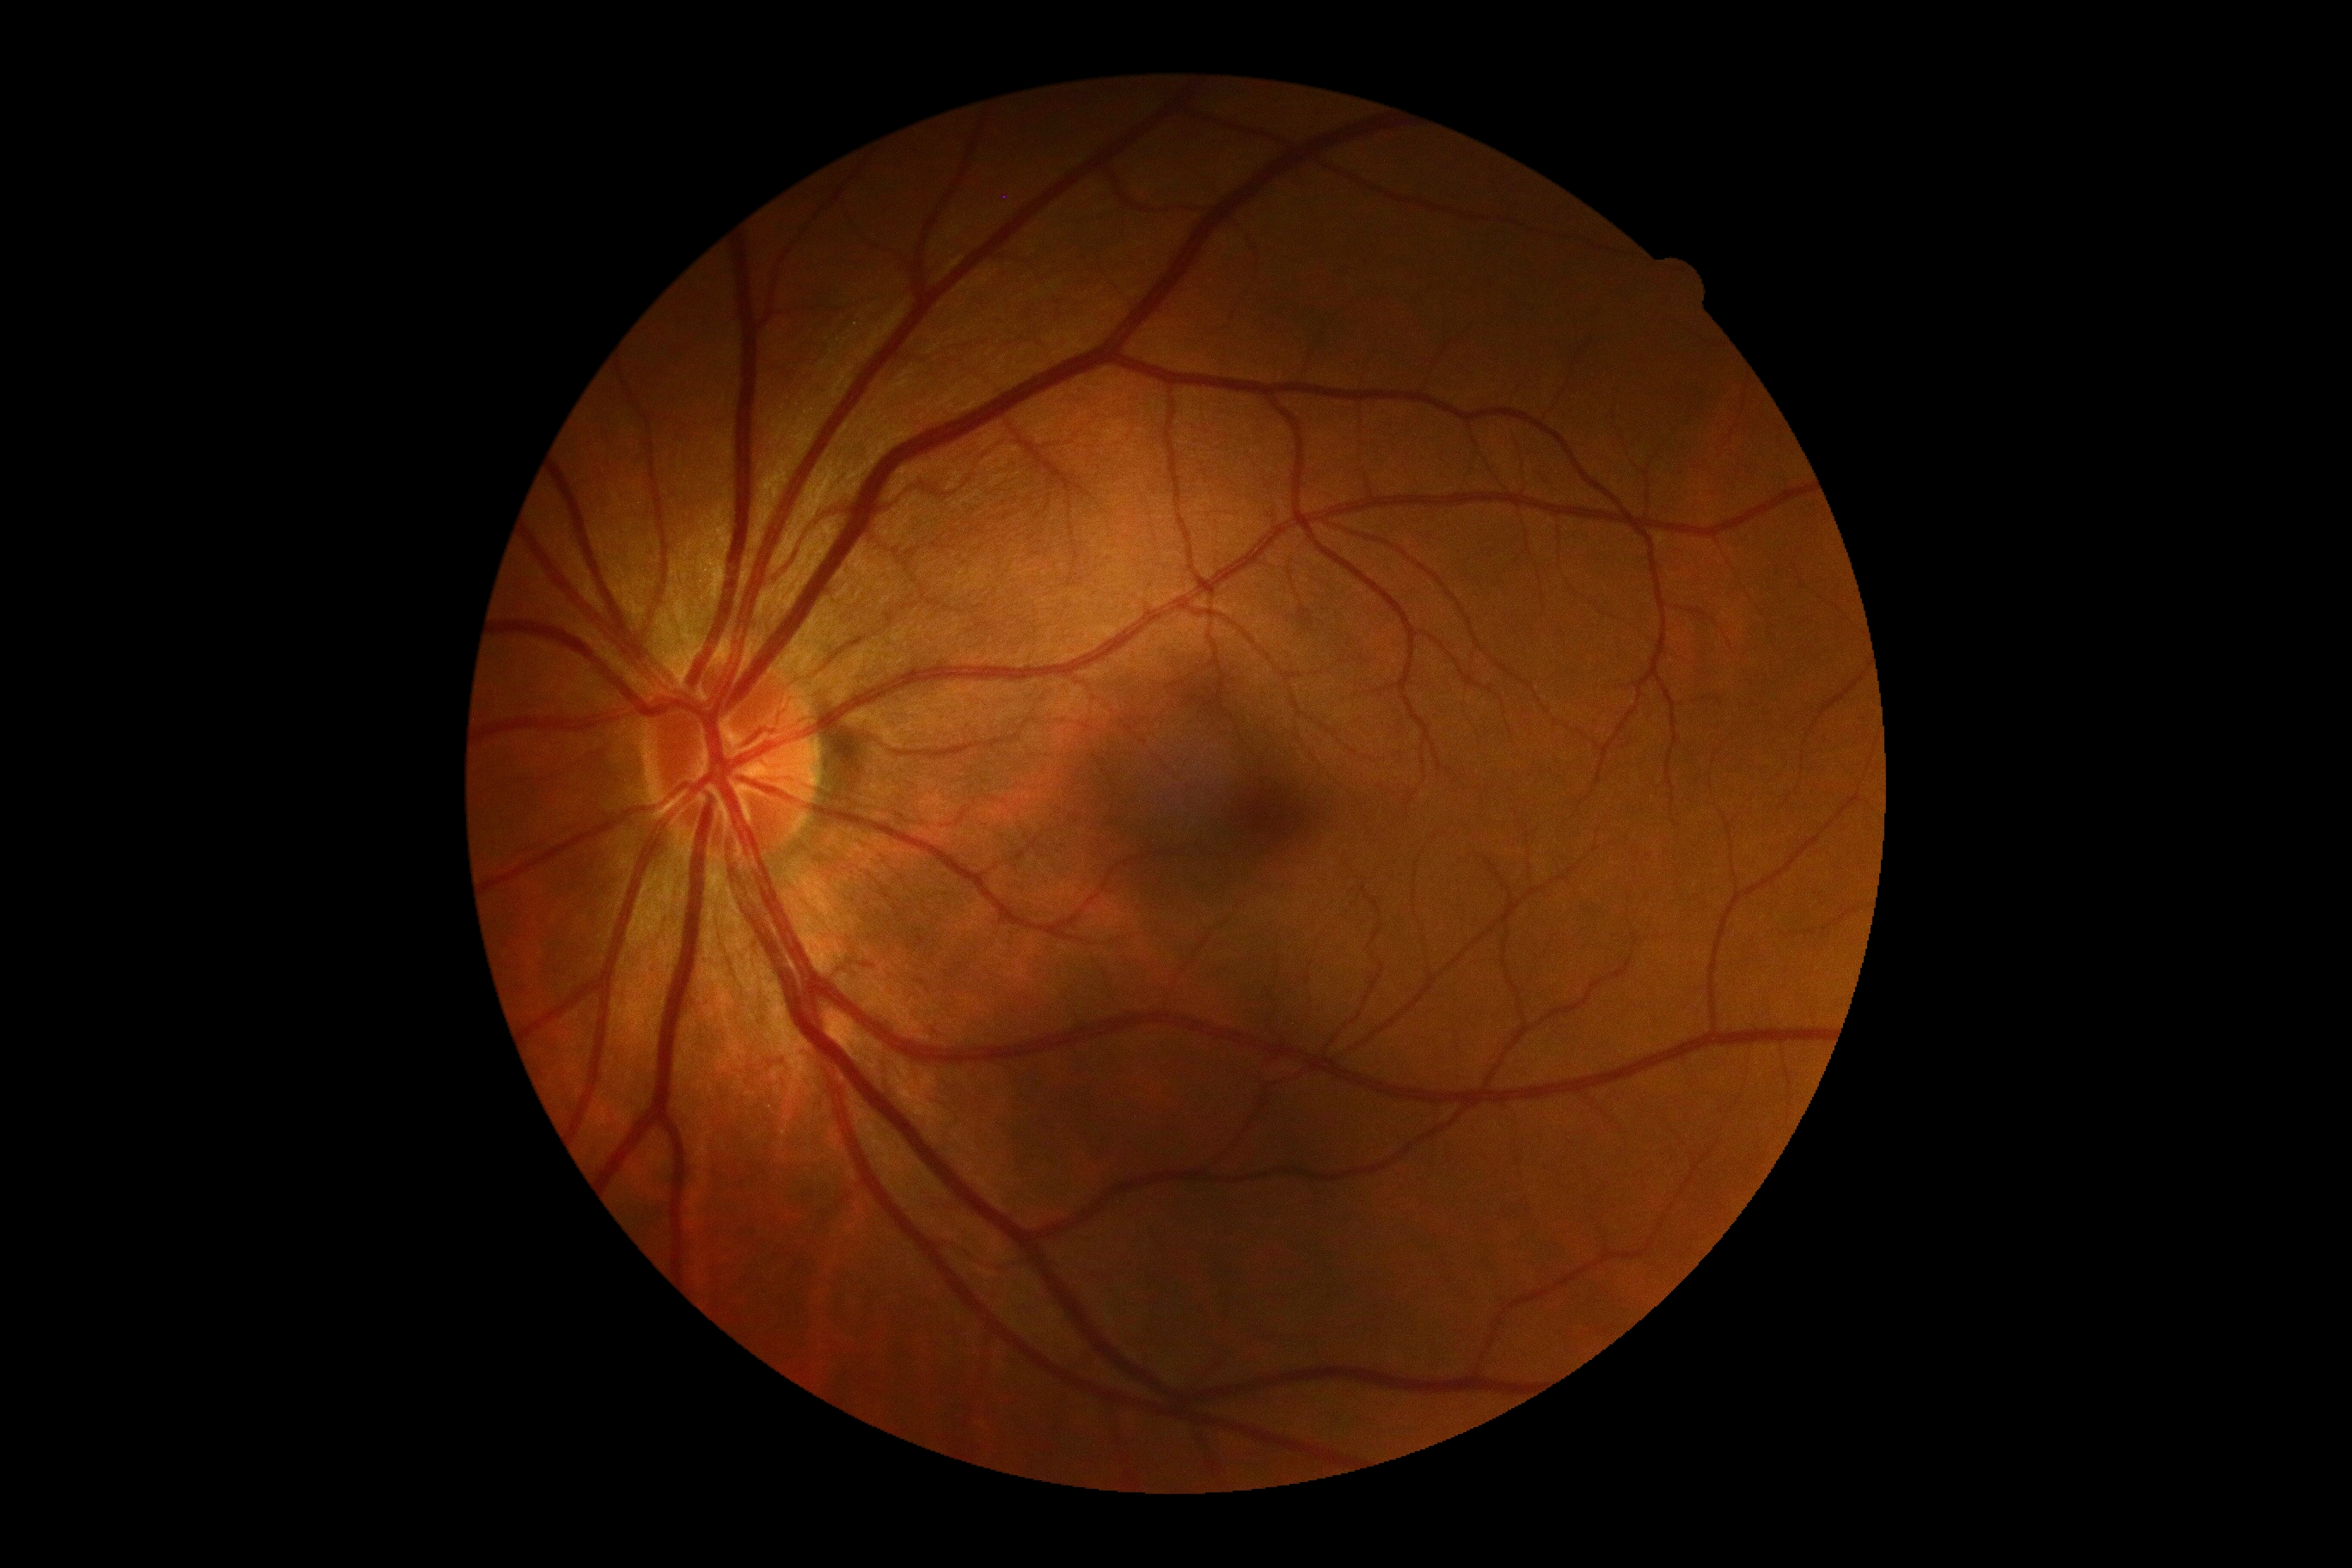
DR stage: no apparent diabetic retinopathy (grade 0).